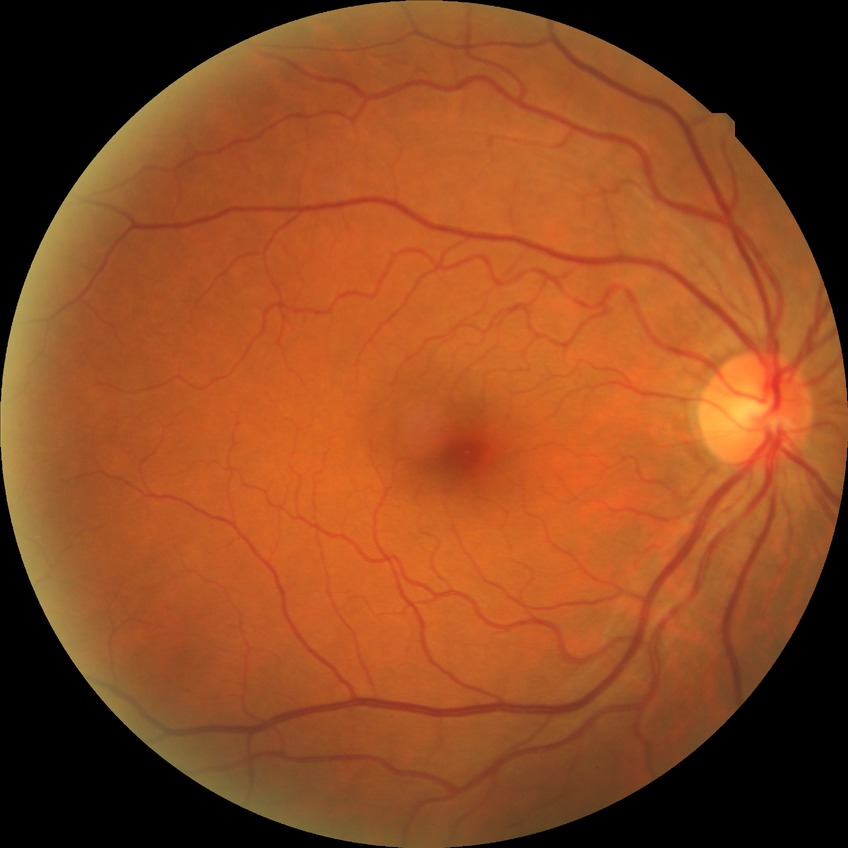
Modified Davis classification is no diabetic retinopathy.